Wide-field contact fundus photograph of an infant · camera: Clarity RetCam 3 (130° FOV) · 640x480
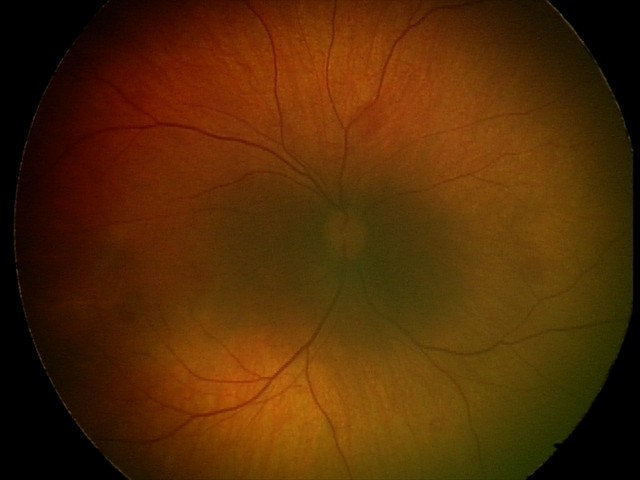

Diagnosis: retinal hemorrhages